Diabetic retinopathy graded by the modified Davis classification.
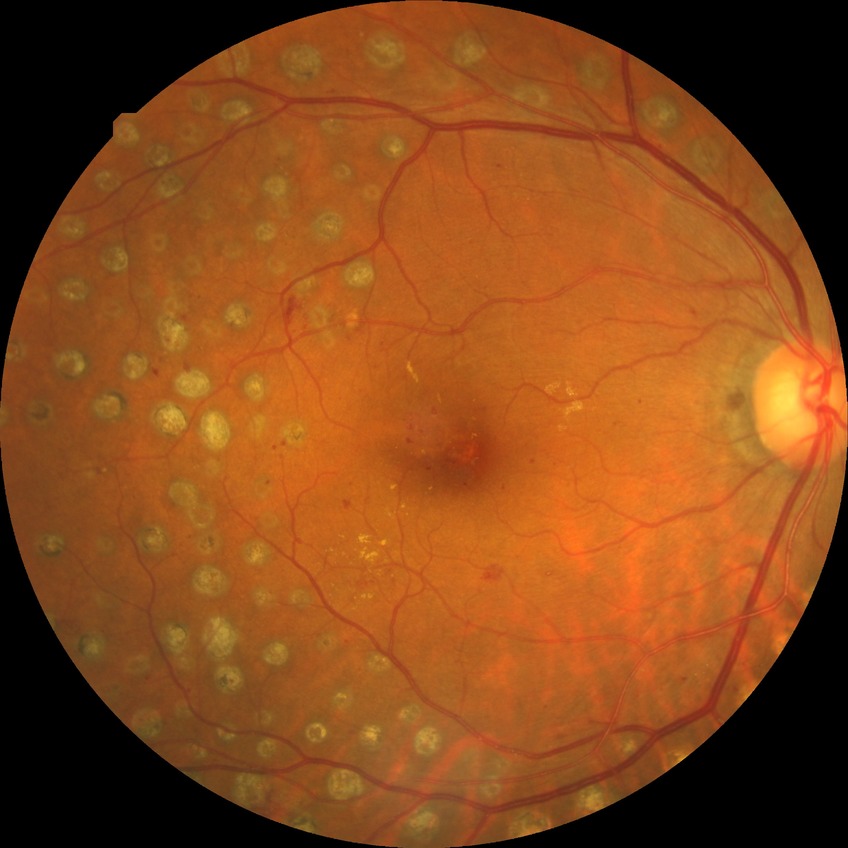

diabetic retinopathy severity=proliferative diabetic retinopathy.